45 degree fundus photograph: 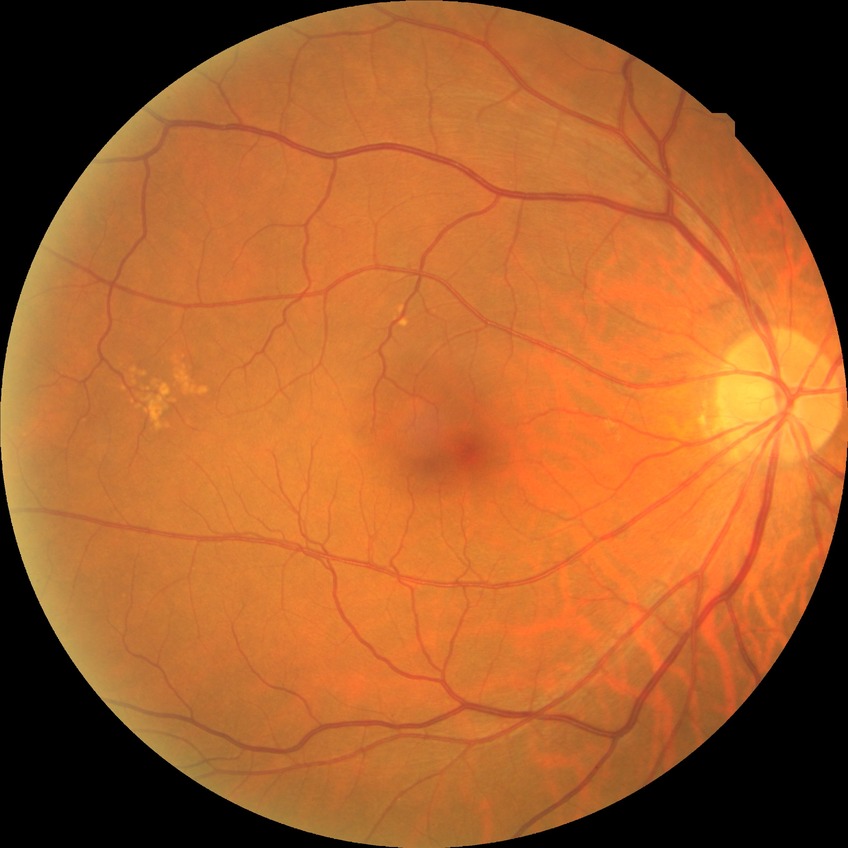
No apparent diabetic retinopathy.
DR severity is NDR.